Graded on the modified Davis scale; NIDEK AFC-230; without pupil dilation; 848 x 848 pixels: 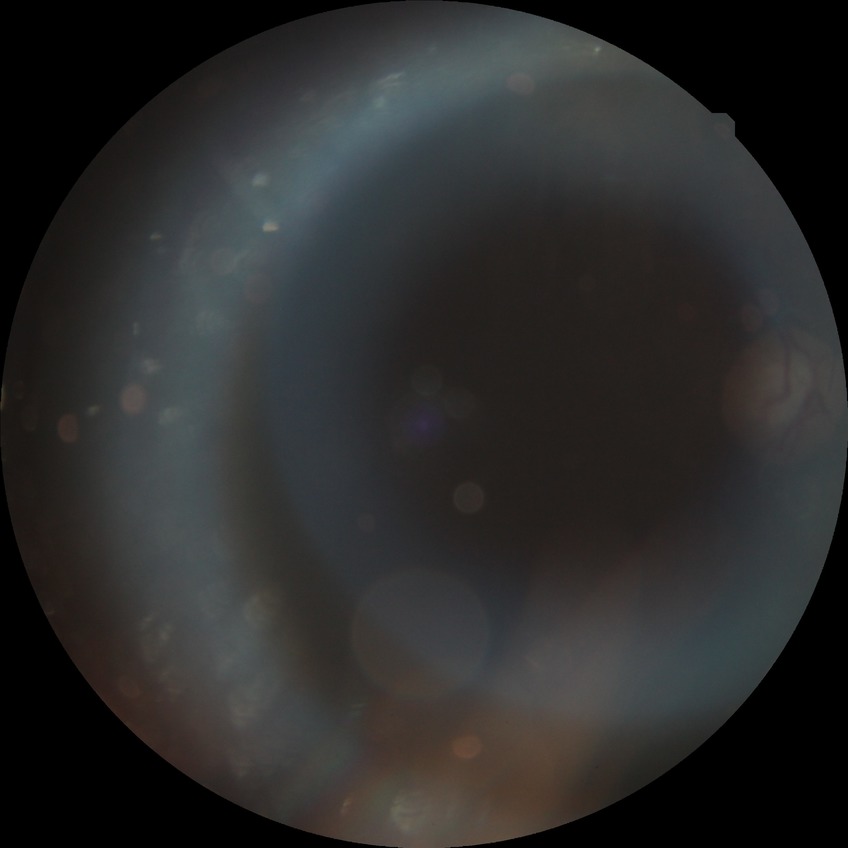

  davis_grade: proliferative diabetic retinopathy